Posterior pole color fundus photograph, 848 by 848 pixels:
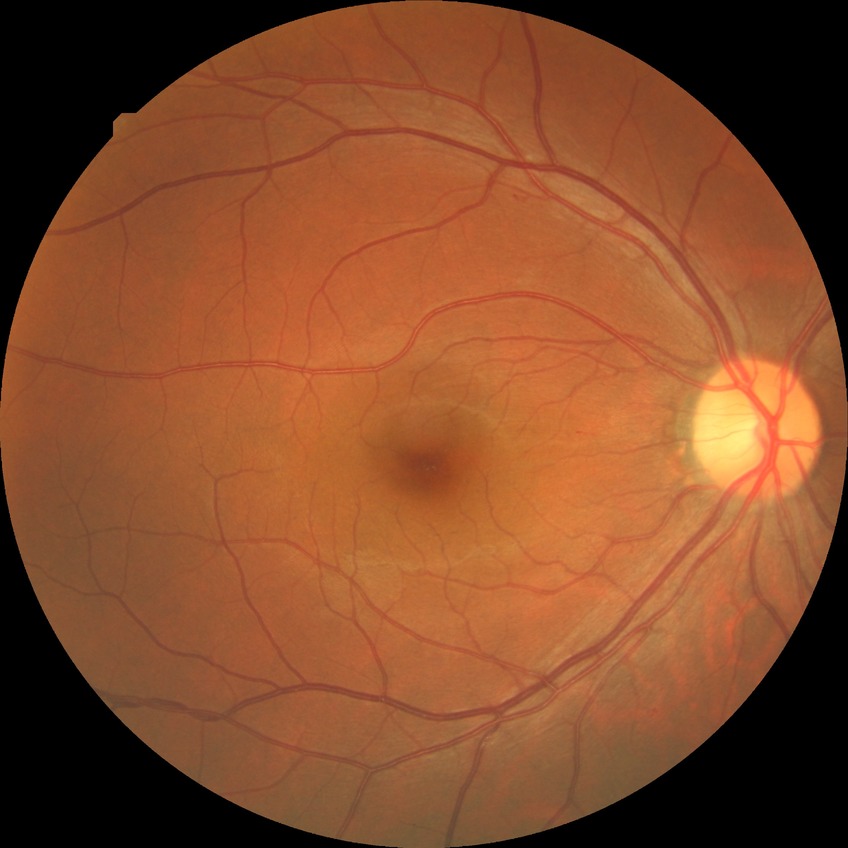
Retinopathy stage: no diabetic retinopathy.